FOV 35° before cropping, ONH-centered crop from a color fundus image — 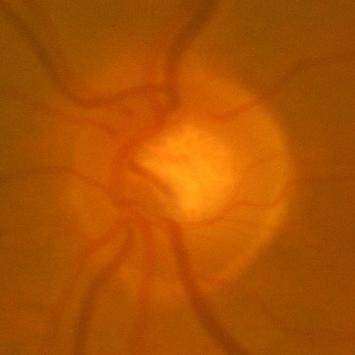

Glaucoma diagnosis = no evidence of glaucoma.